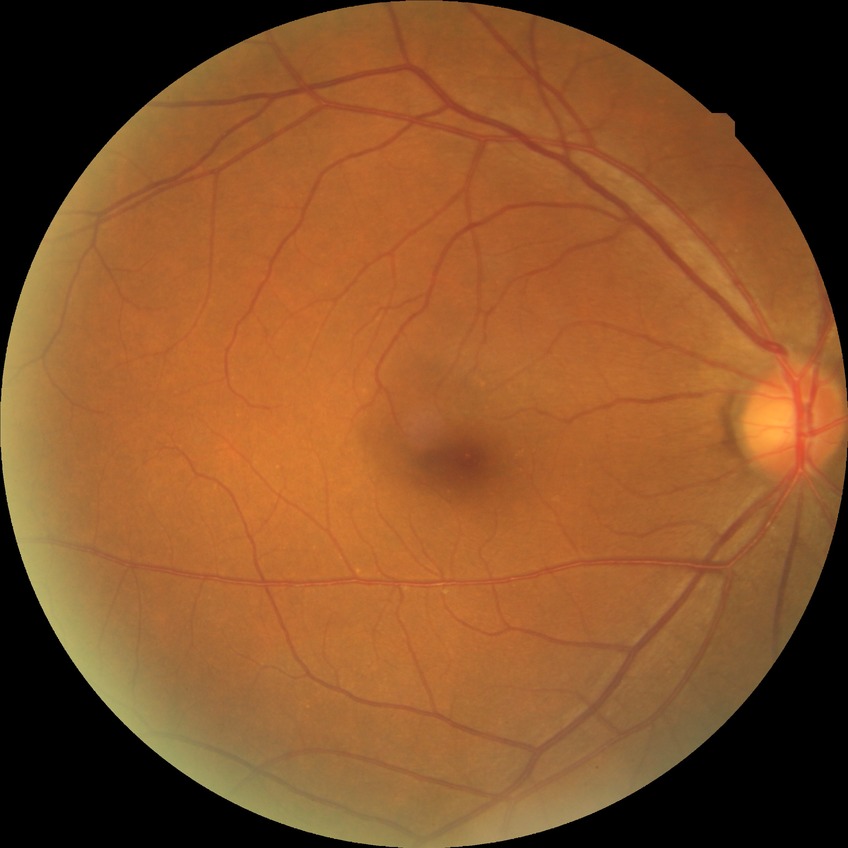
Diabetic retinopathy (DR) is NDR (no diabetic retinopathy).